Fundus photo — 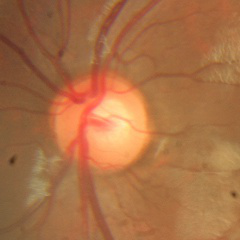
There is evidence of no glaucomatous findings.